Color fundus image:
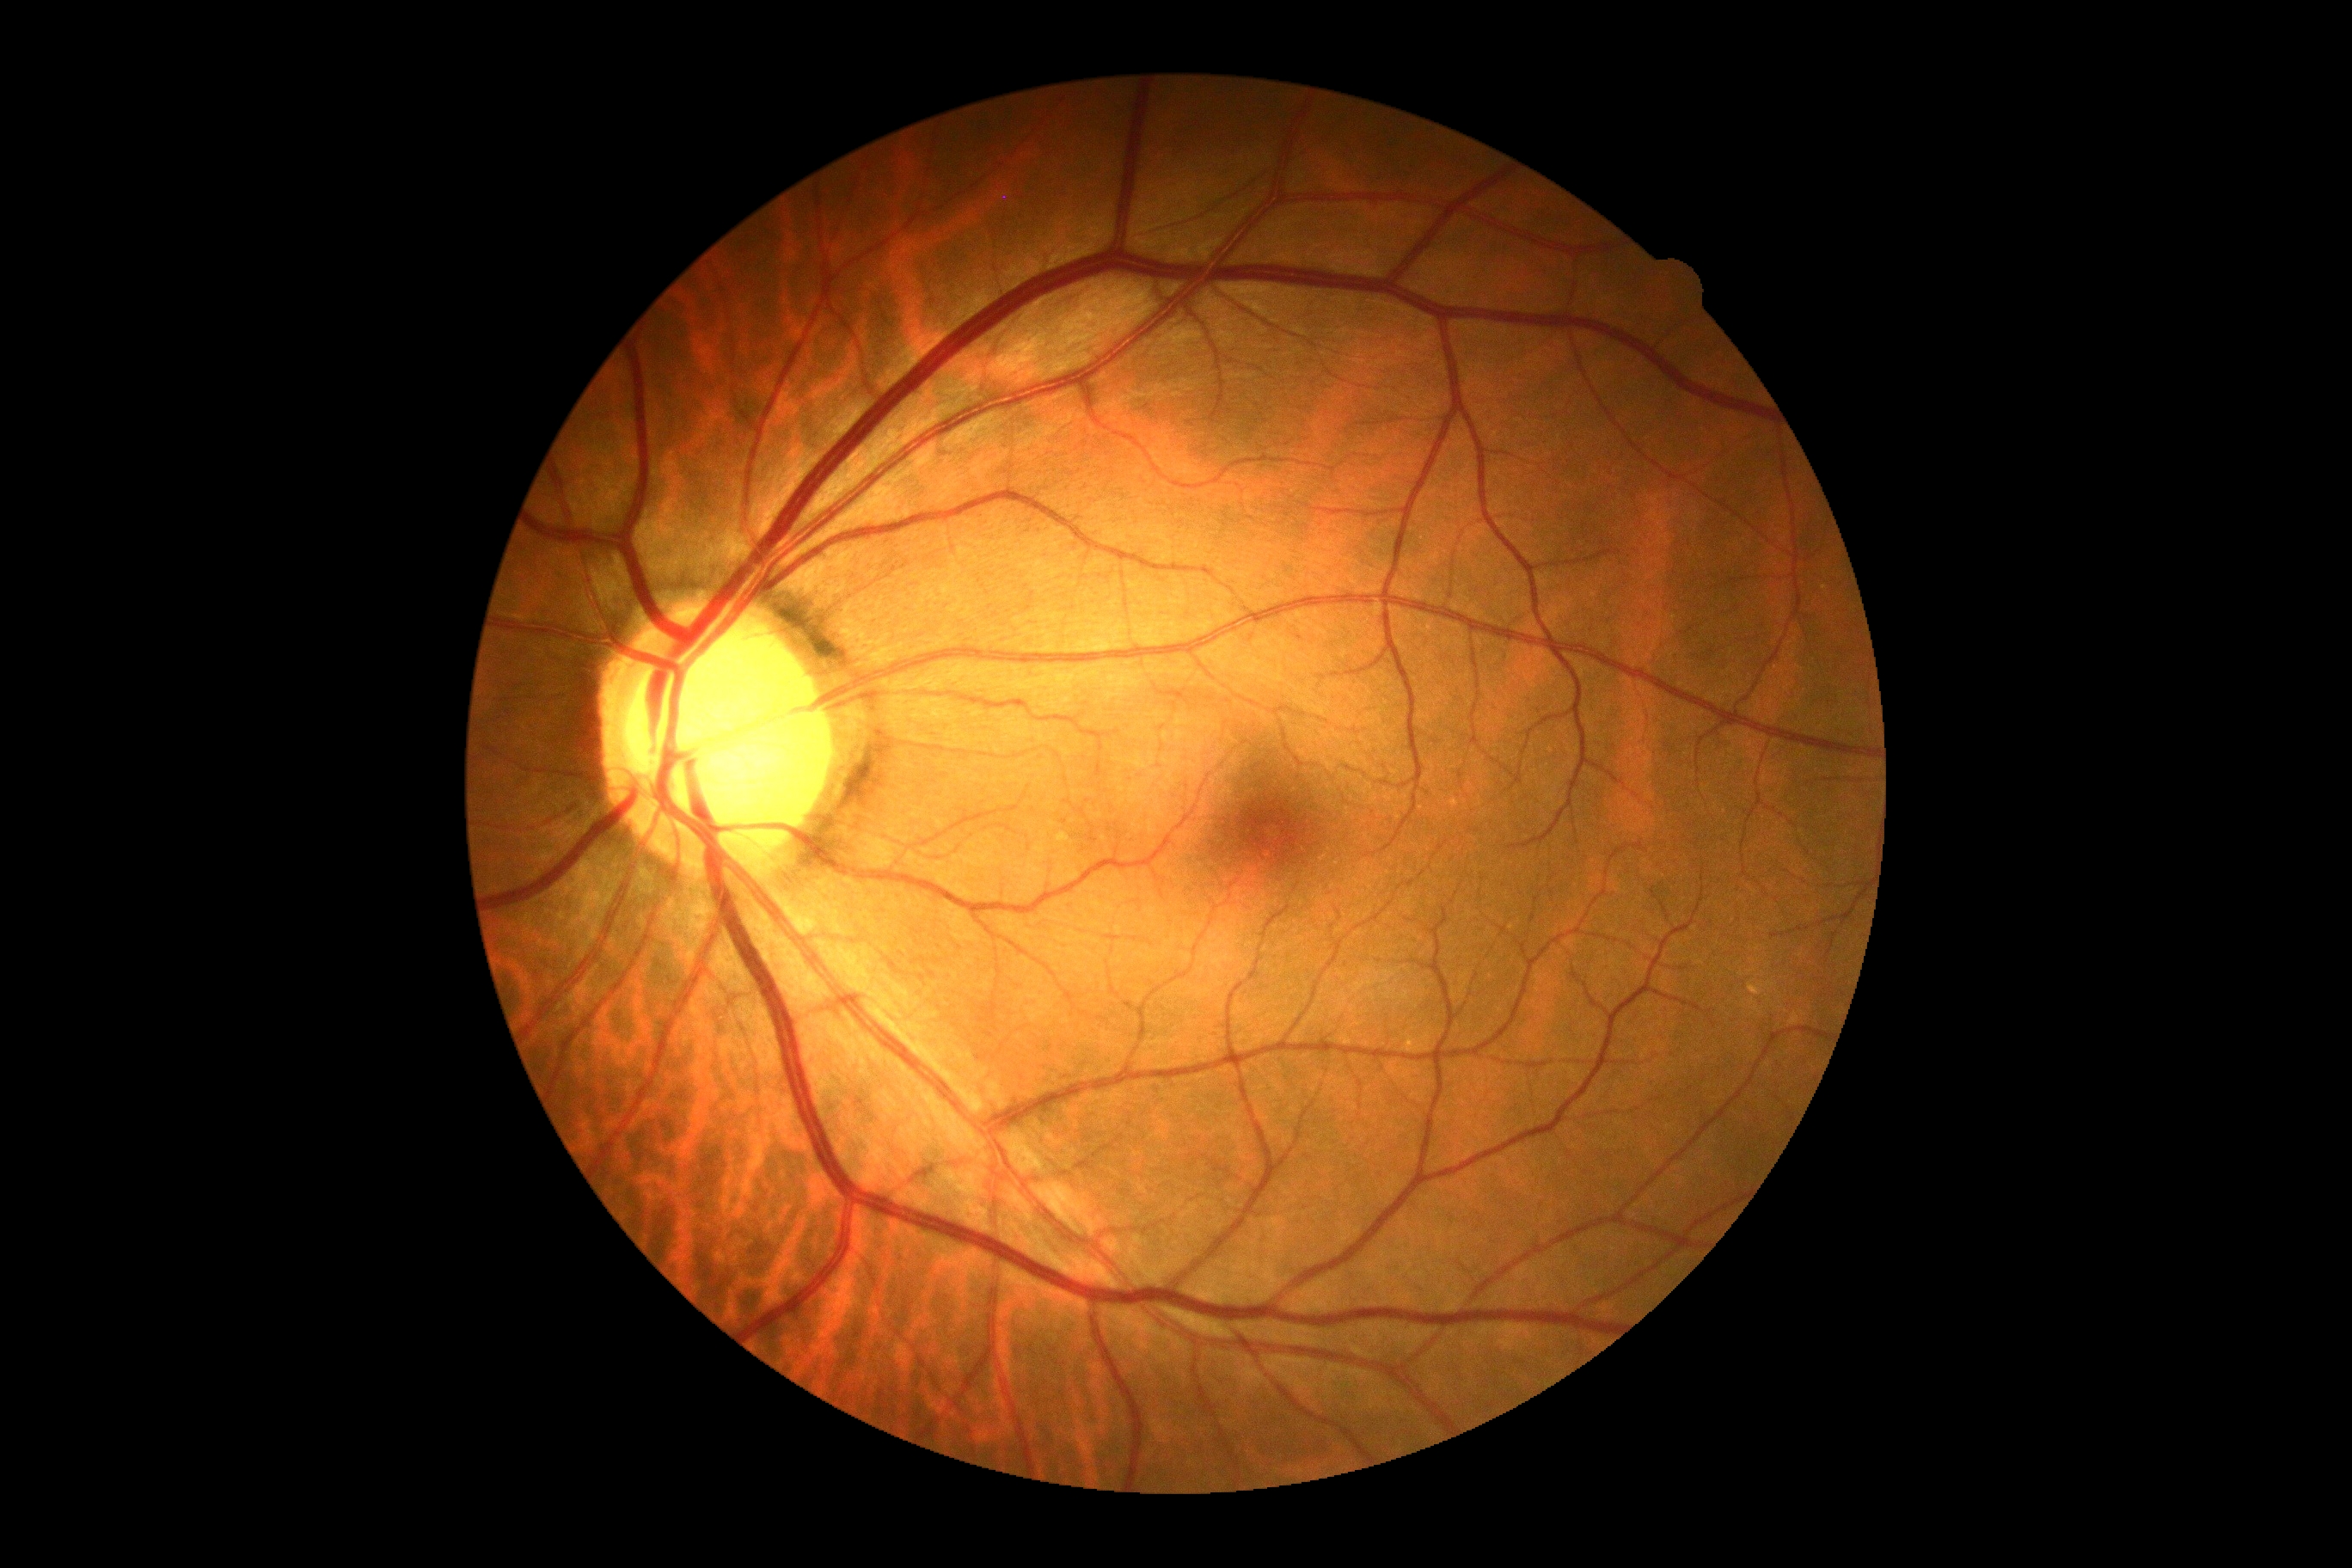
DR grade: no apparent diabetic retinopathy (0).